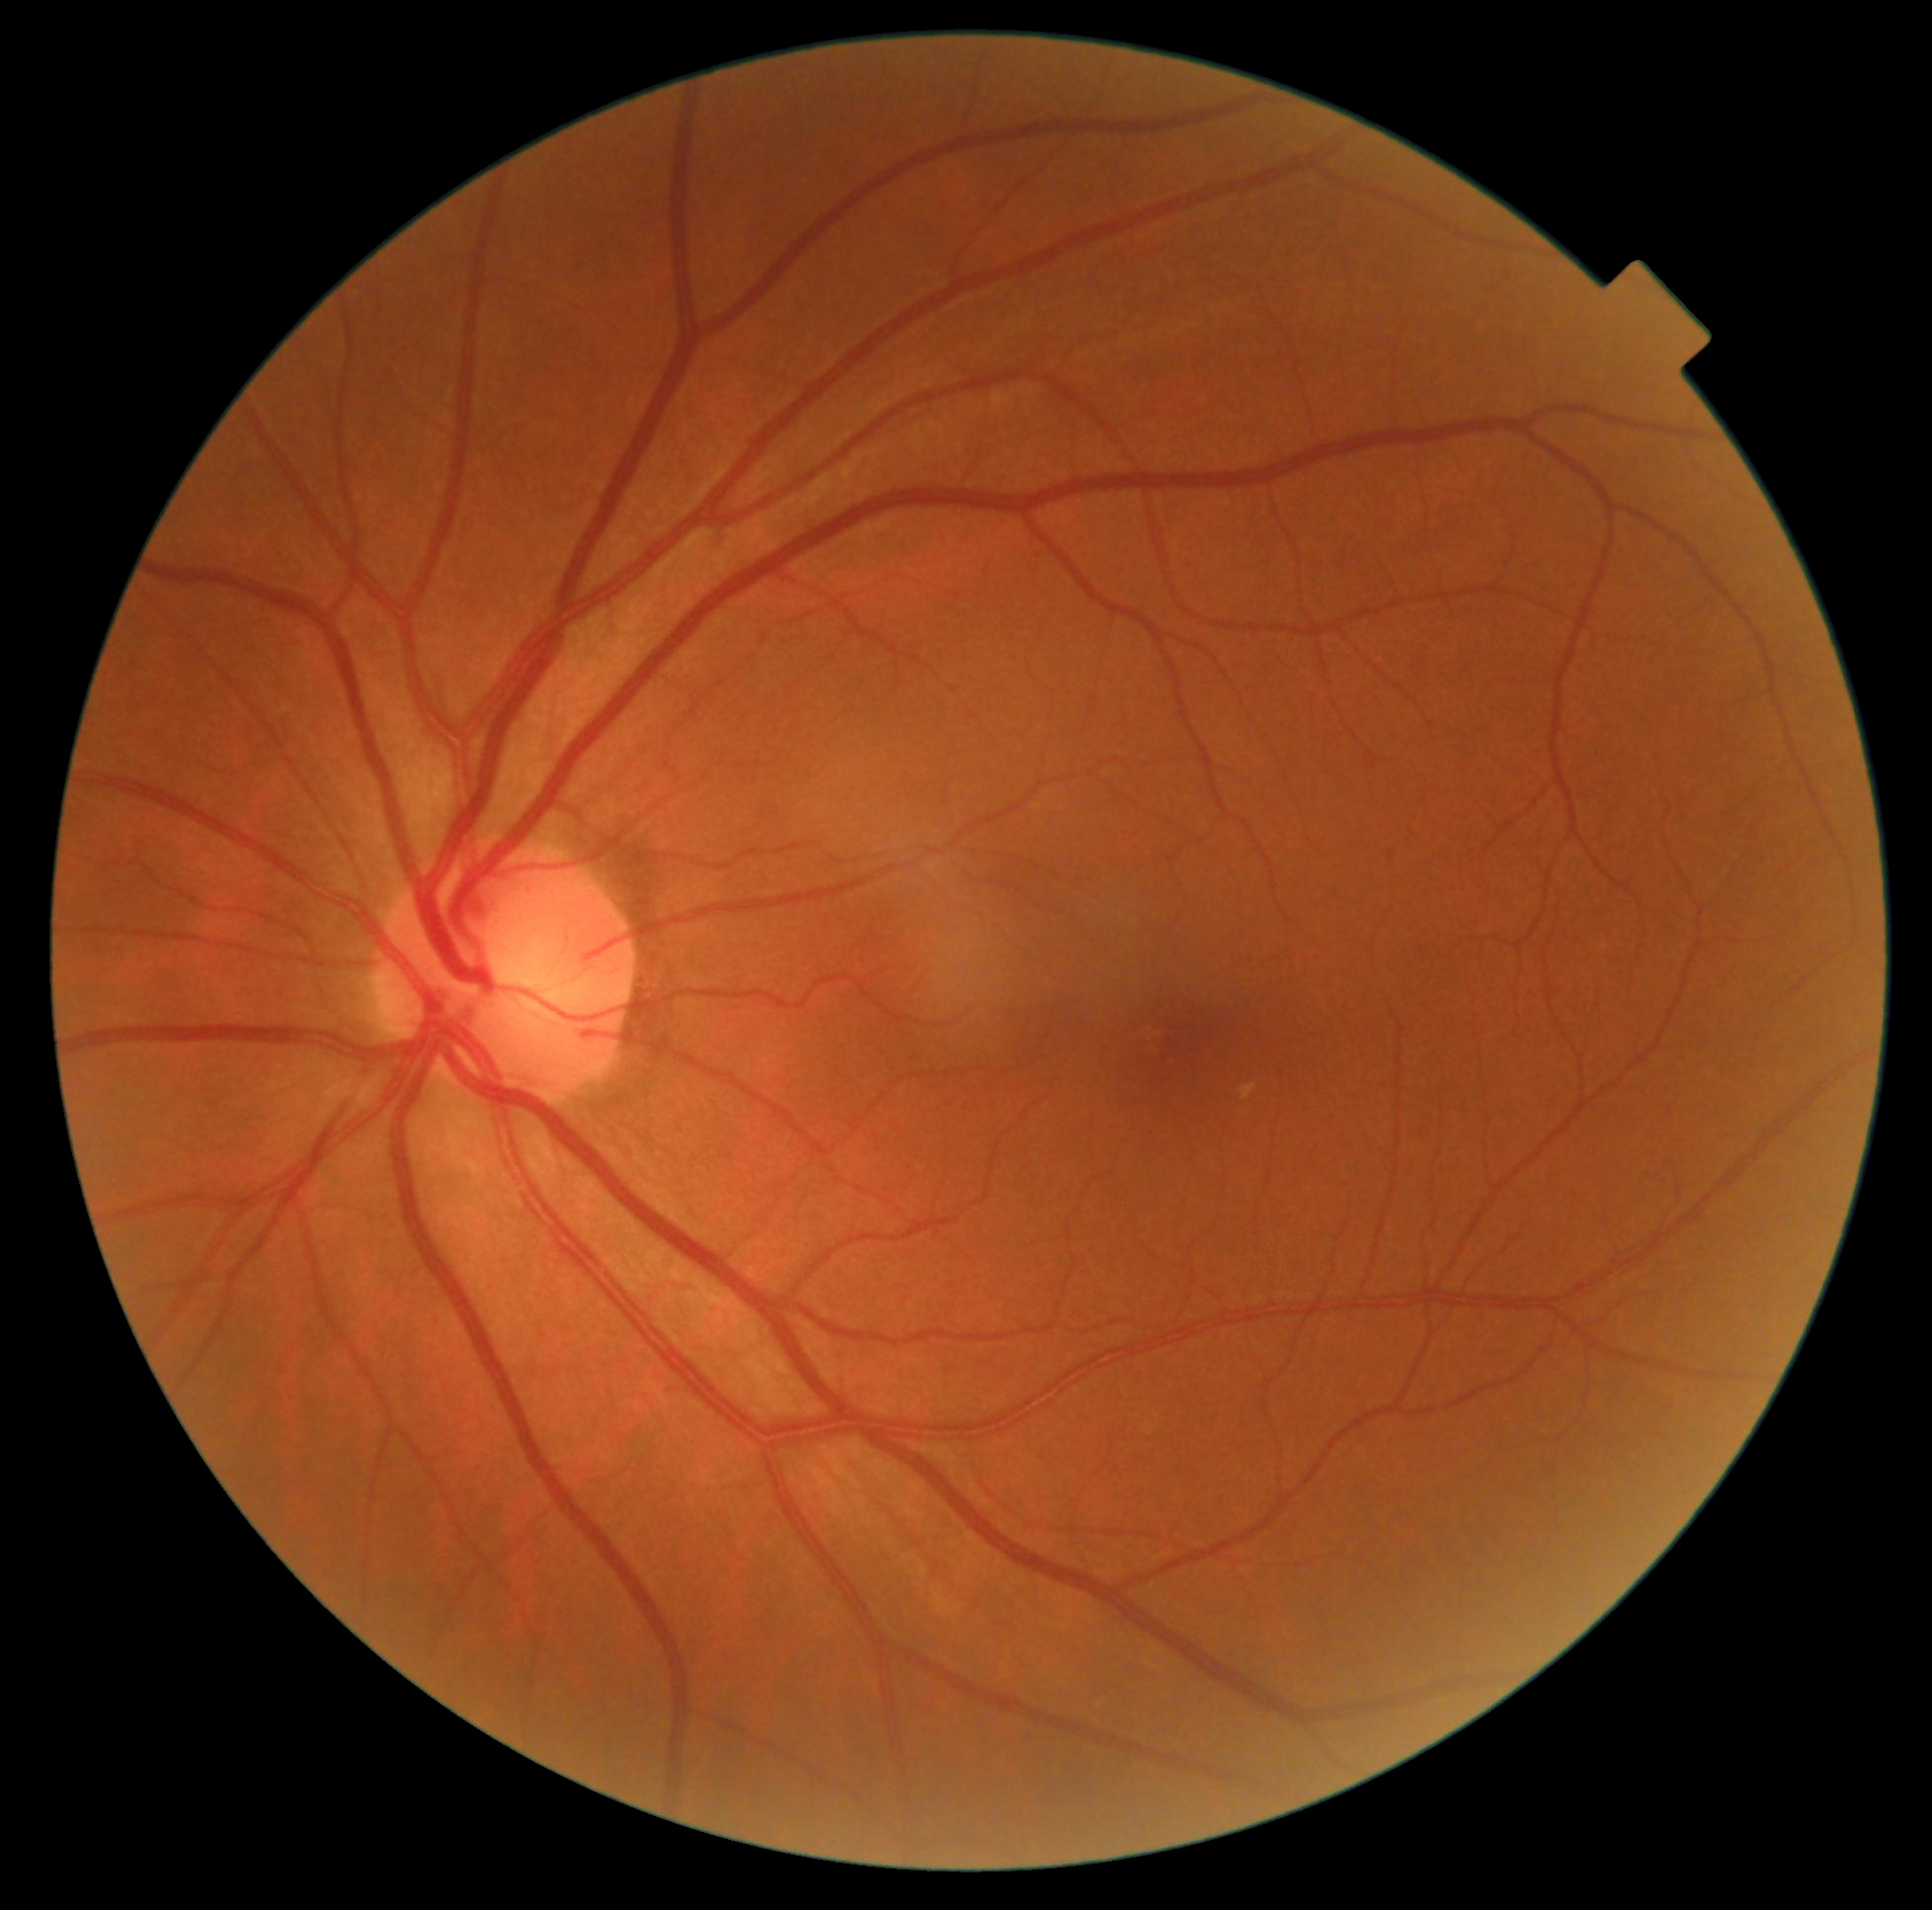 DR stage: no apparent diabetic retinopathy (grade 0) — no visible signs of diabetic retinopathy.